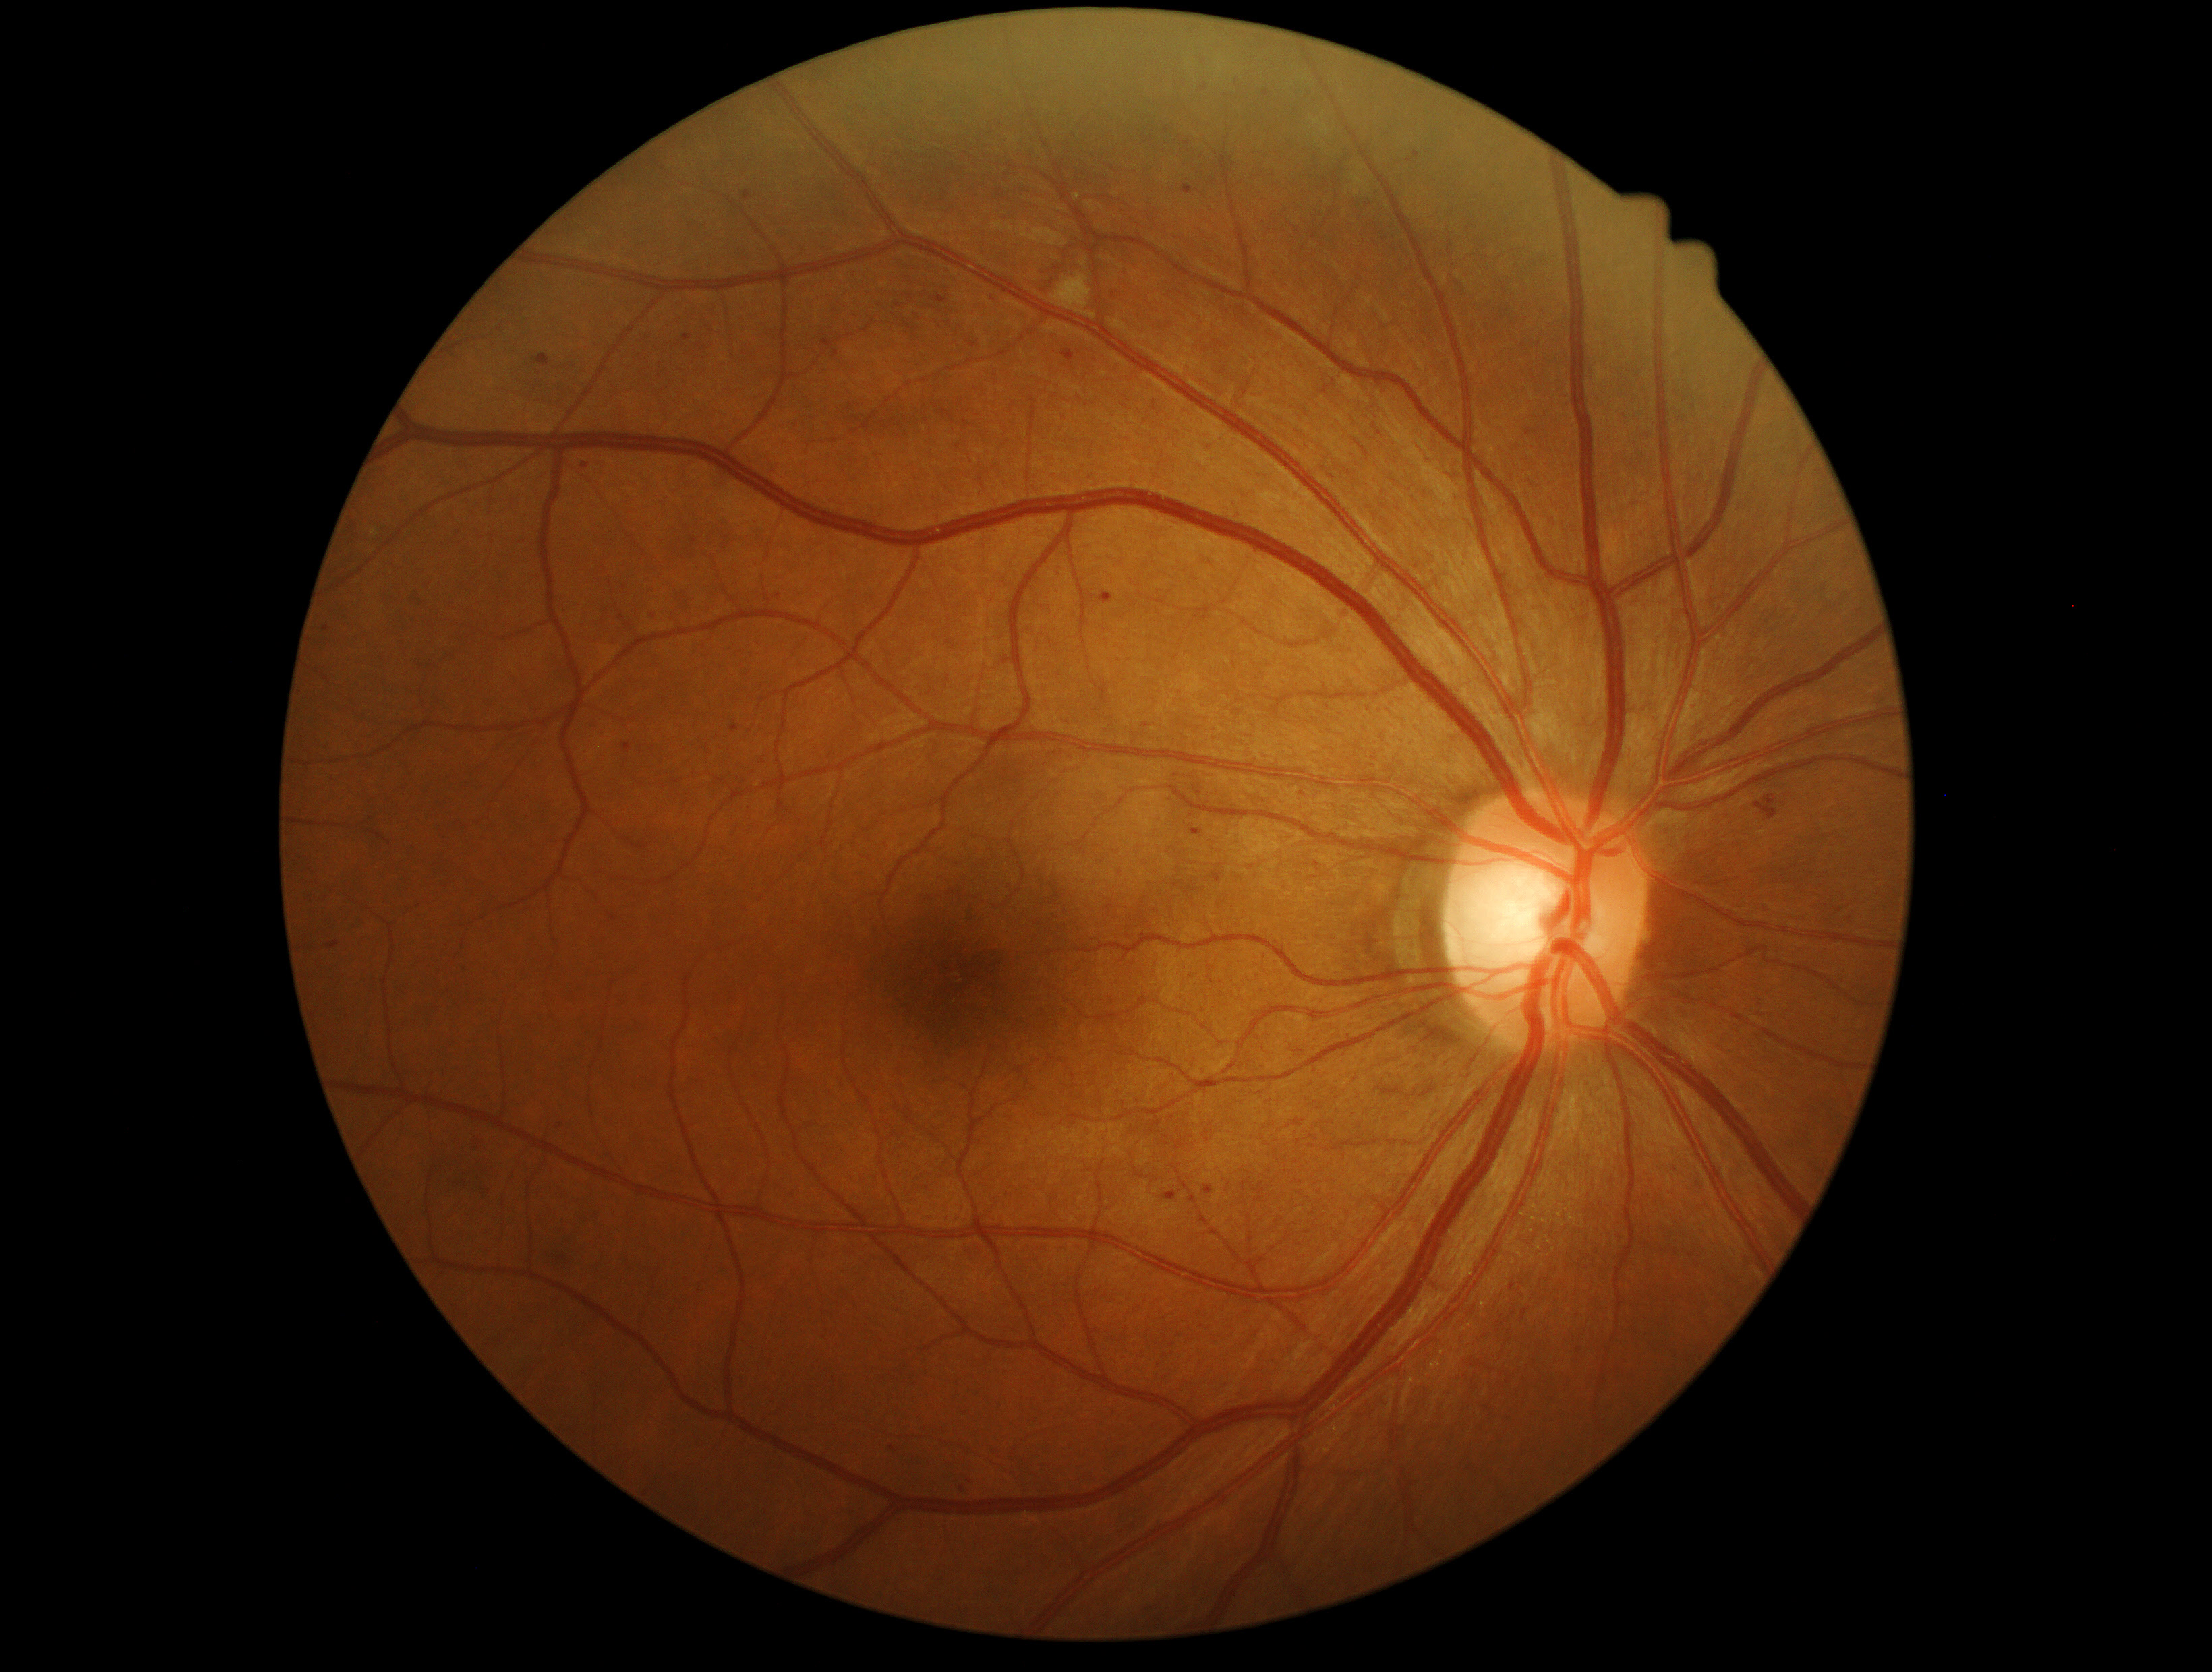

{"partial": true, "dr_grade": 2, "dr_grade_name": "moderate NPDR", "lesions": {"ma": [[730, 726, 740, 733], [1211, 872, 1223, 884], [323, 625, 331, 632], [622, 742, 633, 753], [1204, 1186, 1213, 1195], [1194, 785, 1201, 796], [1264, 91, 1270, 99], [1061, 349, 1076, 363], [1163, 1193, 1177, 1201]], "ma_small": [[963, 1490], [1303, 794], [893, 1449], [687, 338]]}}